Captured on a Topcon TRC-NW8 fundus camera · 50-degree field of view
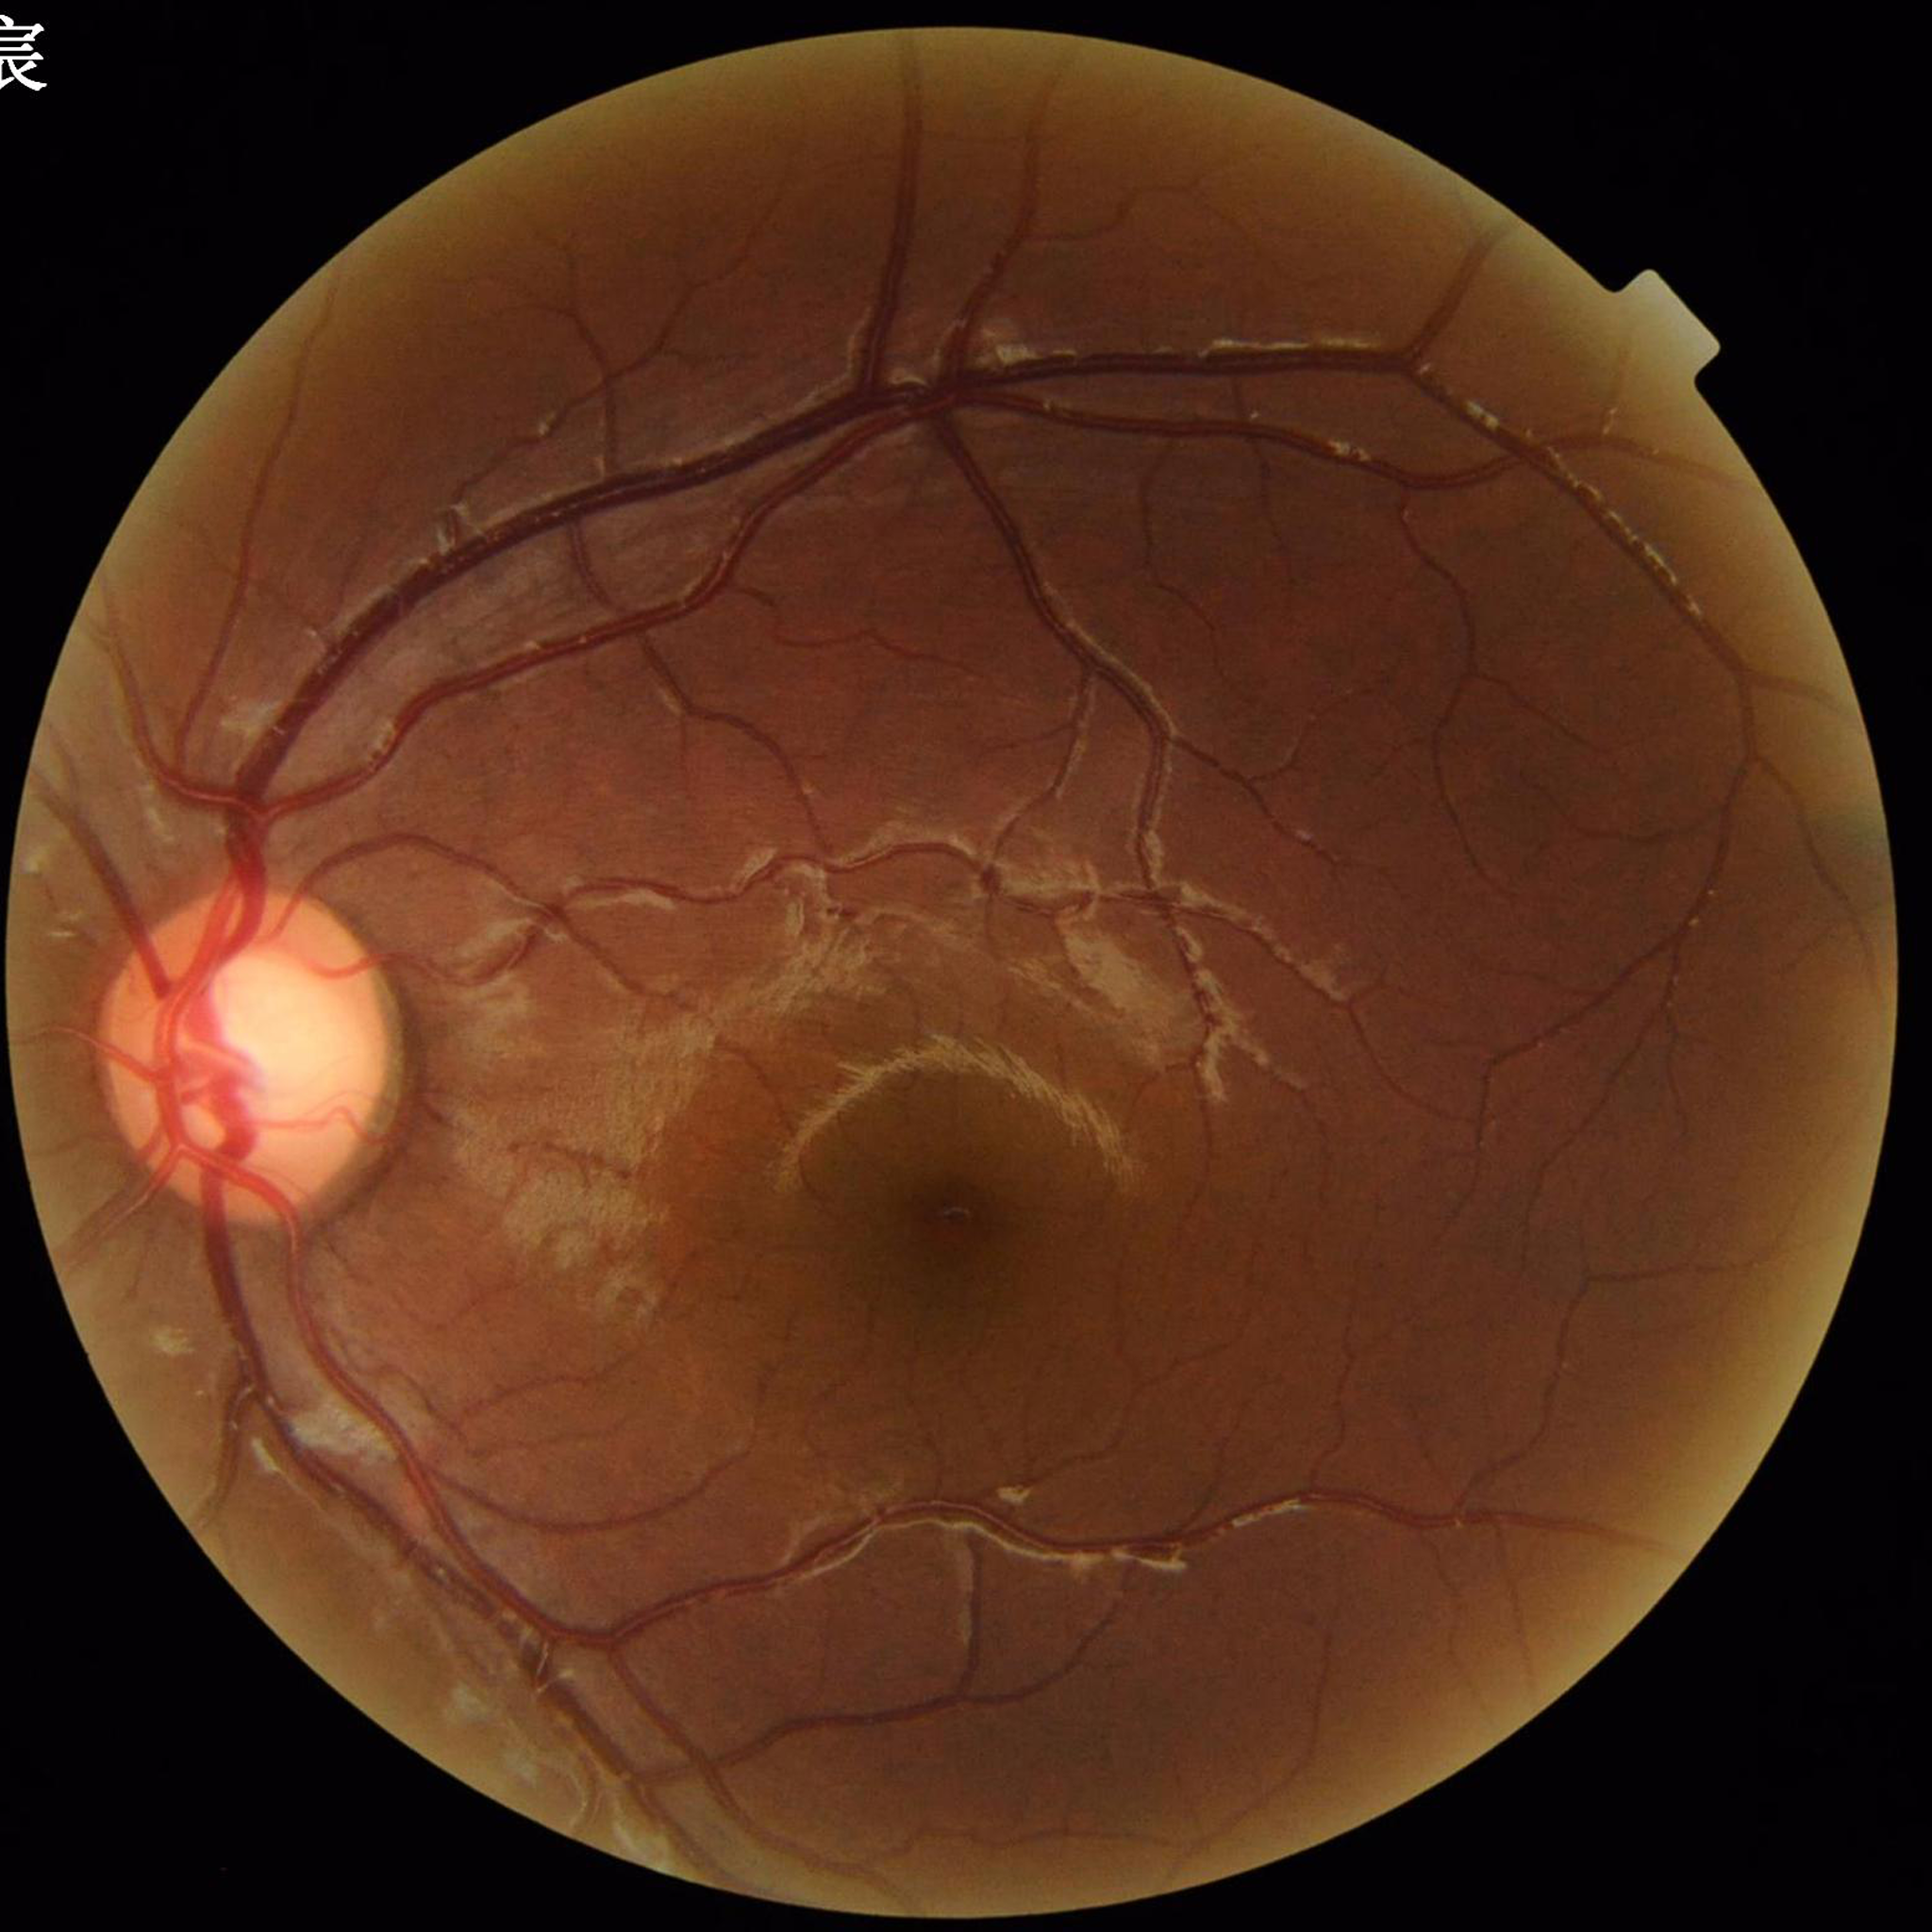
Control patient without diagnosed AMD, DR, or glaucoma.